45-degree field of view; color fundus photograph.
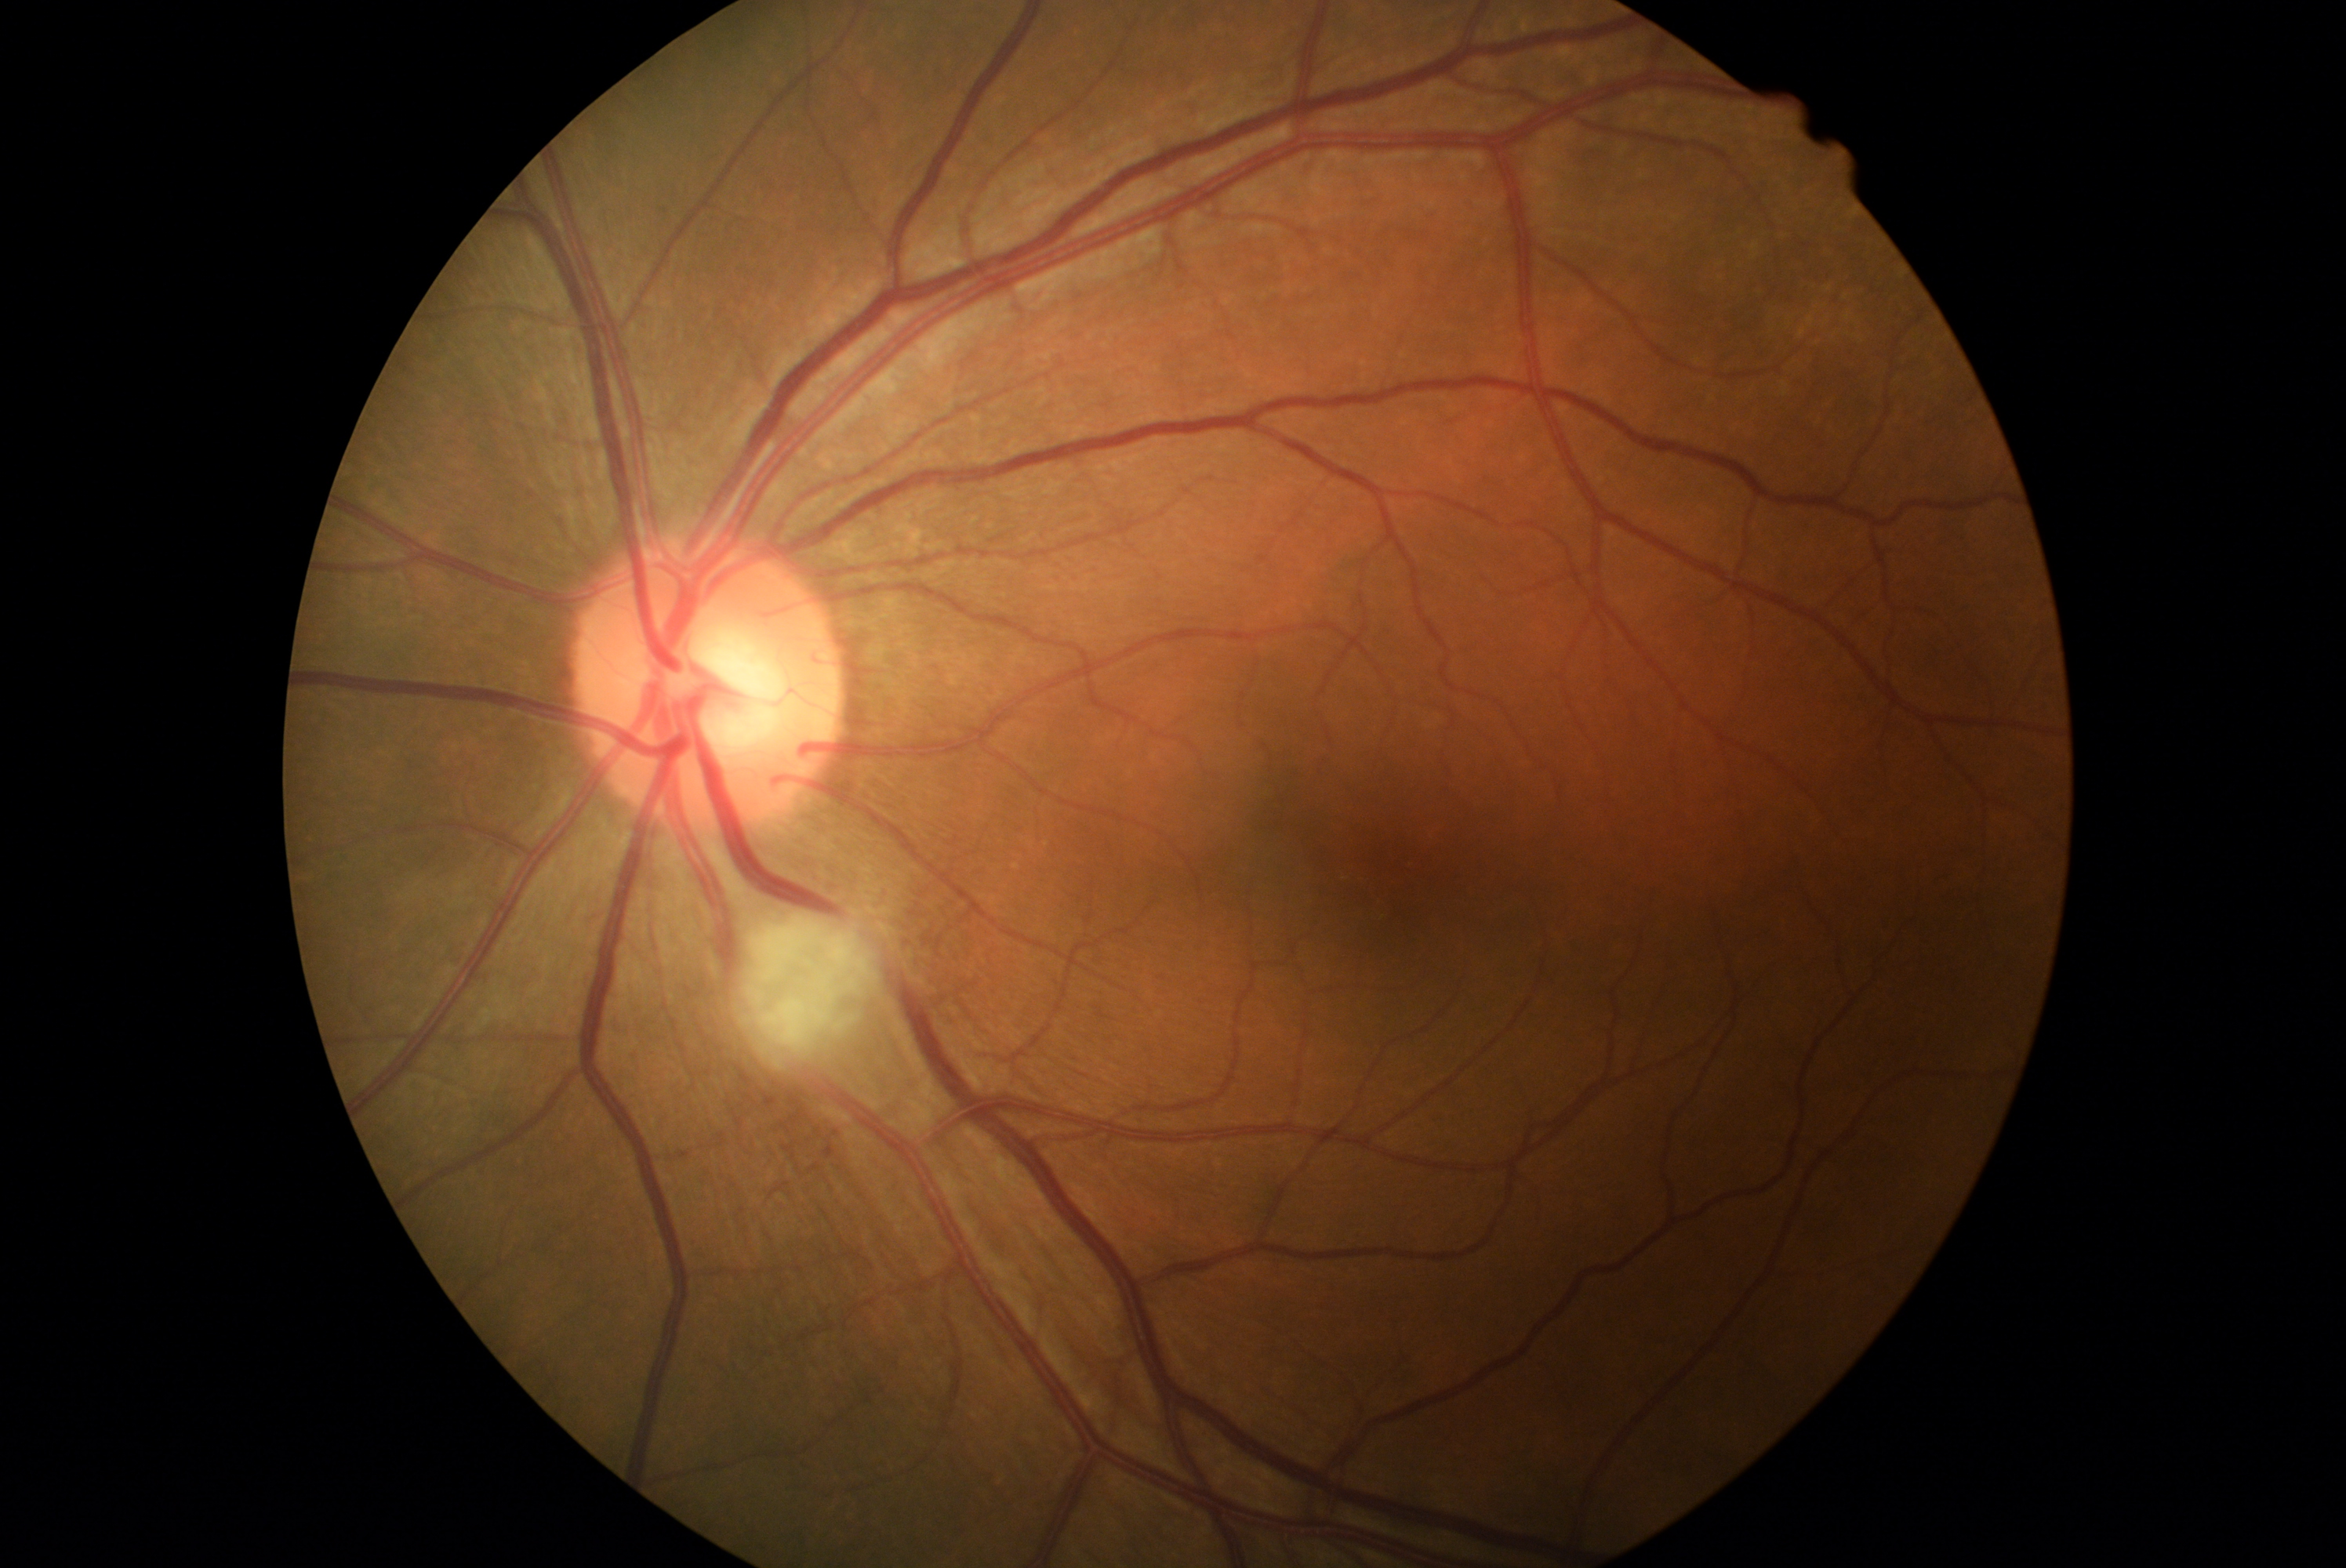 Disease class: non-proliferative diabetic retinopathy. Diabetic retinopathy (DR) is grade 2.